Color fundus image — 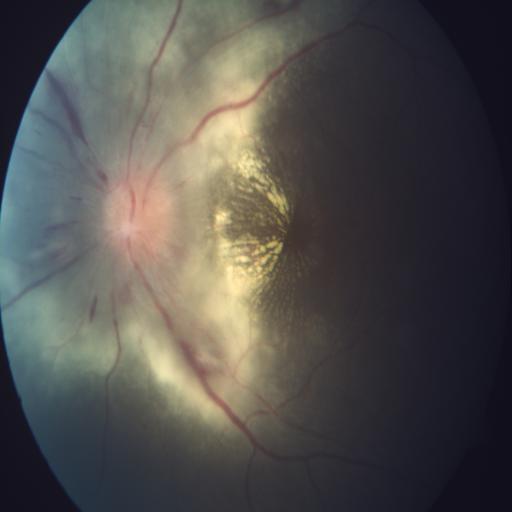

There is evidence of optic neuritis & exudation.